848 x 848 pixels, modified Davis classification, NIDEK AFC-230, 45-degree field of view: 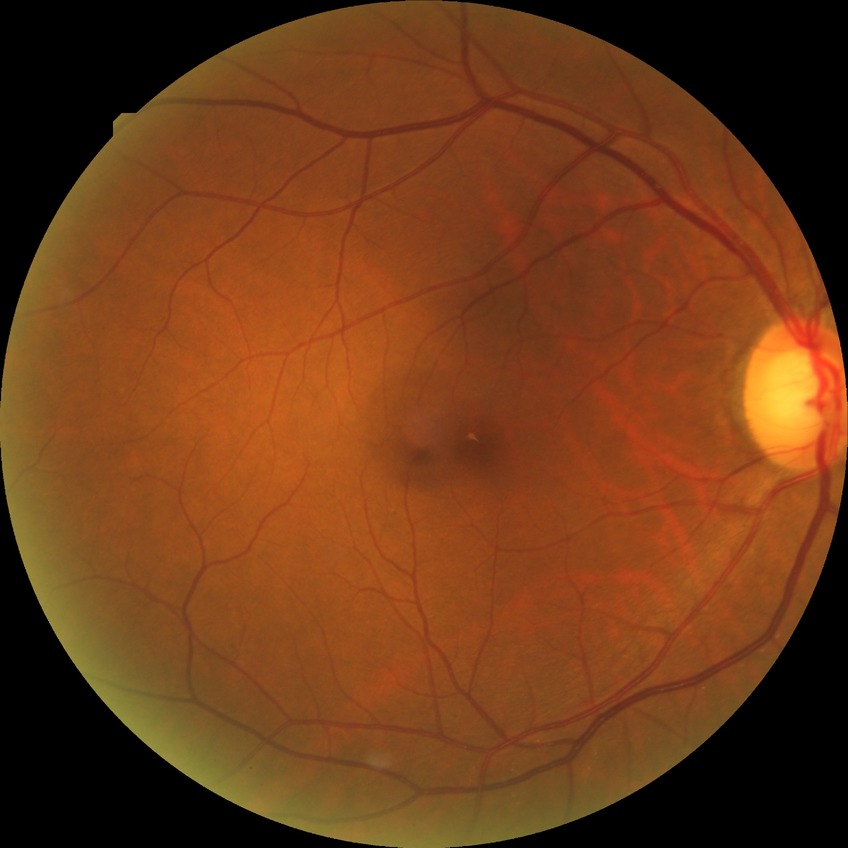 Modified Davis classification is no diabetic retinopathy.